45-degree field of view: 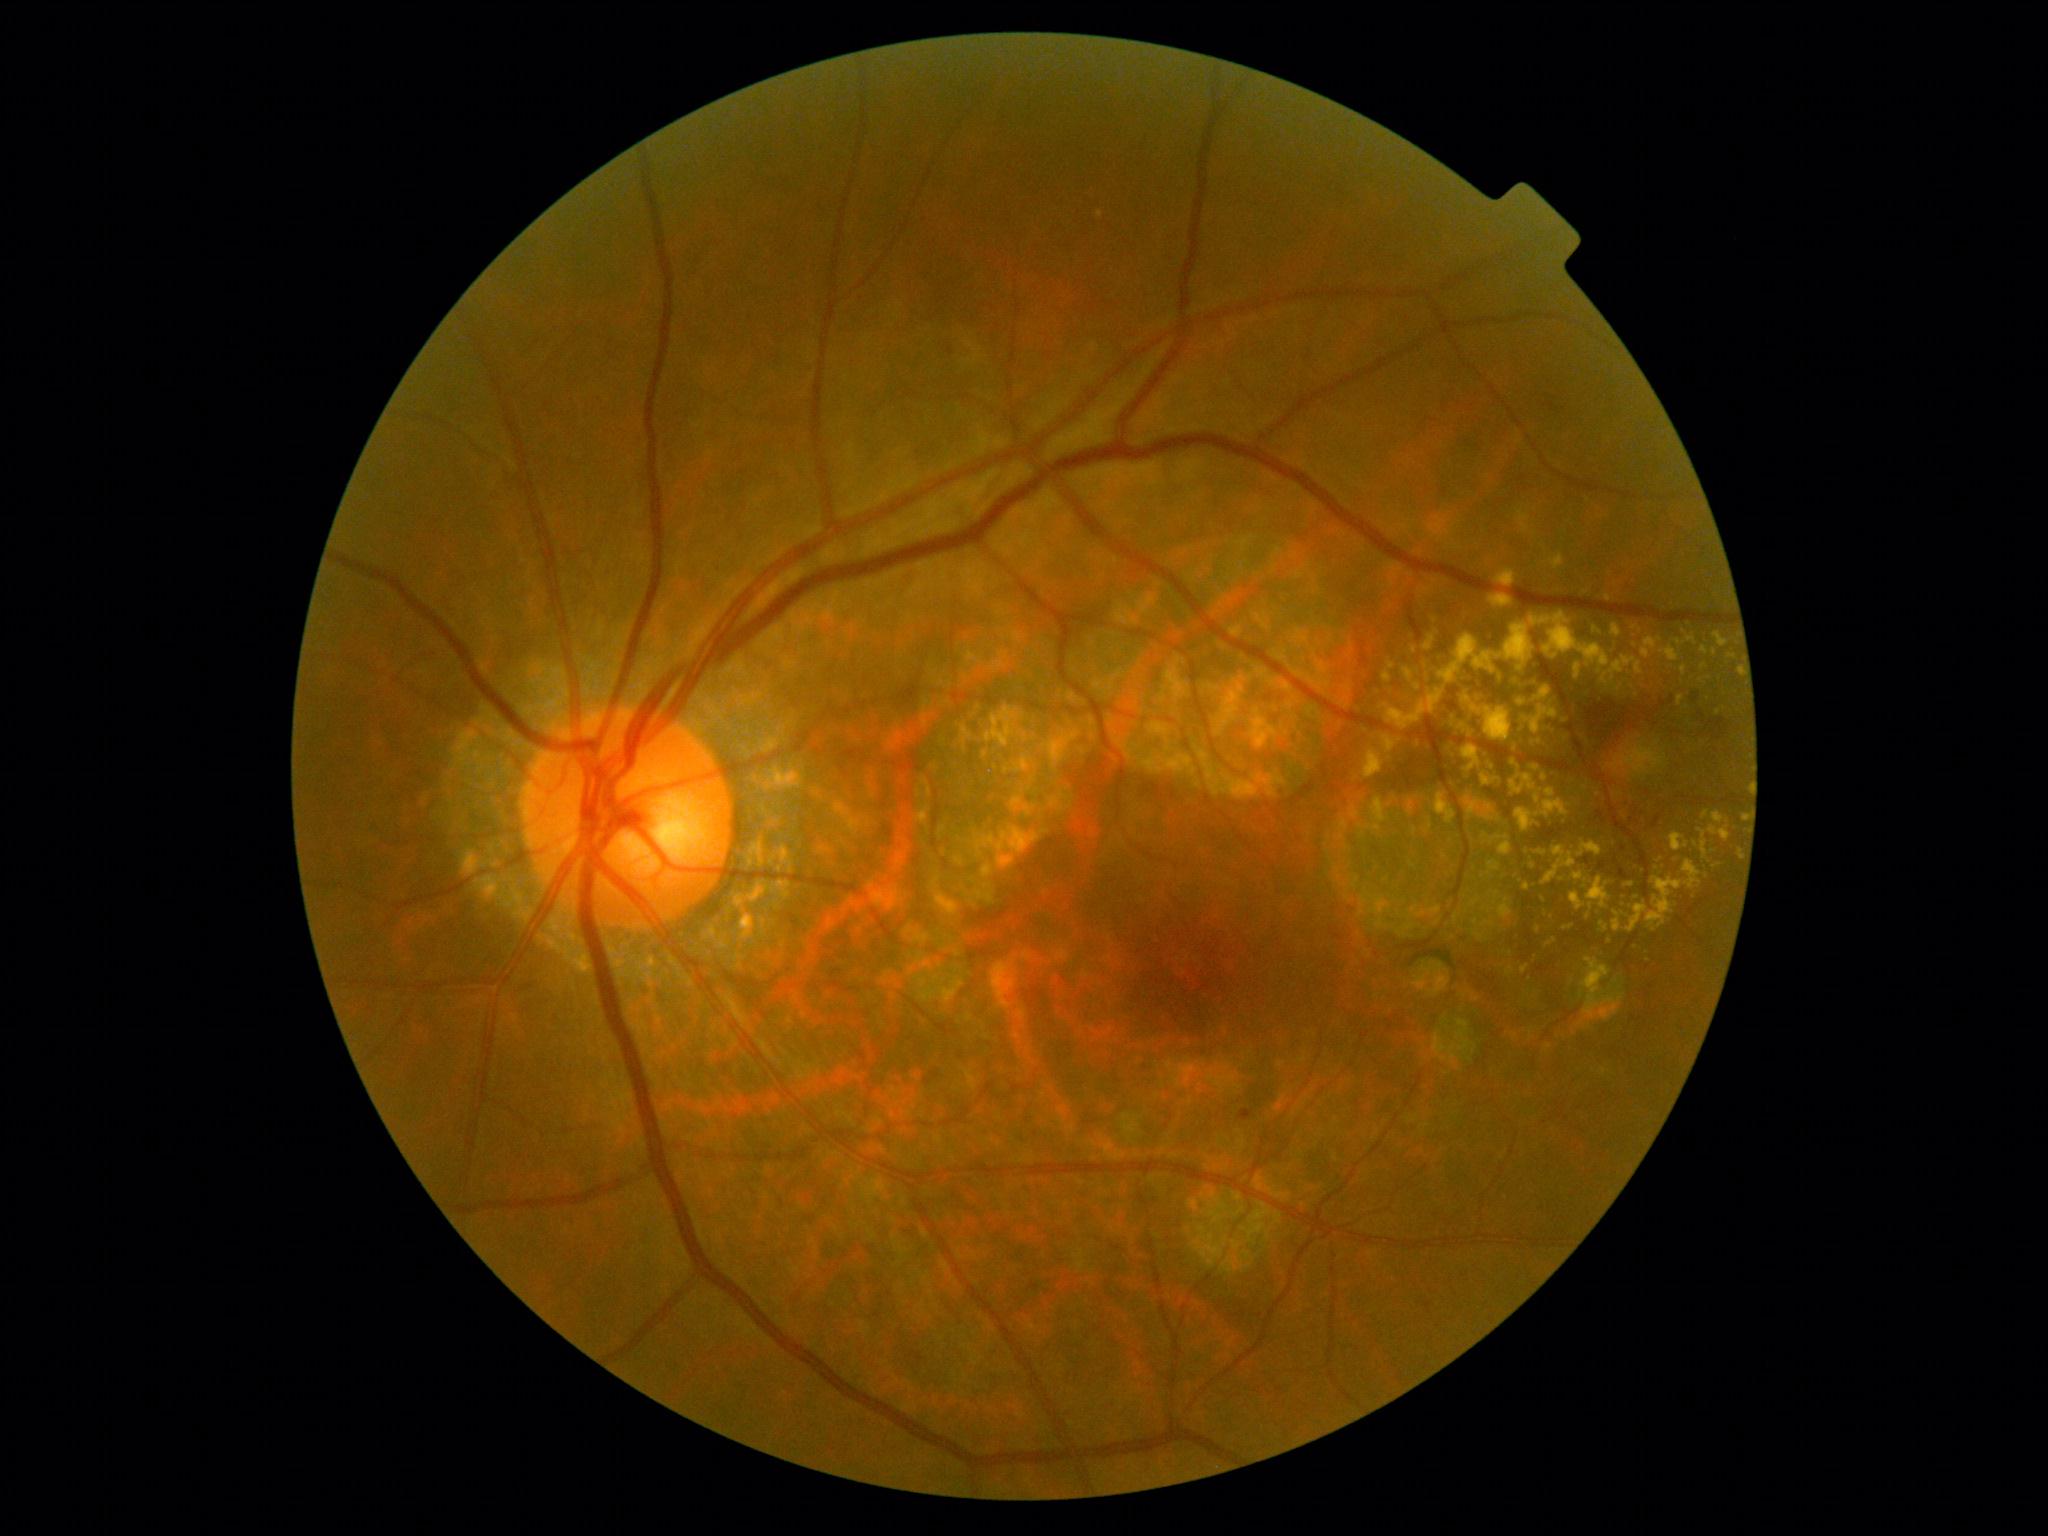
partial: true
dr_grade: 2
dr_grade_name: moderate NPDR
lesions:
  se: []
  he:
    - x1=1652, y1=816, x2=1661, y2=829
    - x1=1703, y1=716, x2=1730, y2=742
    - x1=1691, y1=693, x2=1701, y2=703
    - x1=1599, y1=862, x2=1606, y2=871
    - x1=1670, y1=697, x2=1675, y2=706
    - x1=1585, y1=696, x2=1657, y2=747
  he_small:
    - 1624/849
  ma:
    - x1=1239, y1=1110, x2=1254, y2=1122
  ex:
    - x1=1572, y1=872, x2=1612, y2=910
    - x1=1670, y1=833, x2=1690, y2=852
    - x1=1586, y1=965, x2=1605, y2=981
    - x1=1439, y1=624, x2=1535, y2=684
    - x1=1549, y1=554, x2=1565, y2=571
    - x1=1536, y1=851, x2=1548, y2=856
    - x1=1380, y1=734, x2=1401, y2=755
    - x1=1624, y1=882, x2=1635, y2=888
    - x1=1738, y1=849, x2=1745, y2=861
    - x1=1542, y1=773, x2=1548, y2=782
    - x1=1485, y1=707, x2=1512, y2=742
    - x1=1714, y1=633, x2=1728, y2=648
    - x1=1713, y1=812, x2=1724, y2=823
  ex_small:
    - 1586/788
    - 1746/818
    - 1565/739
    - 1706/876
    - 1660/861
    - 1719/713
    - 1427/675